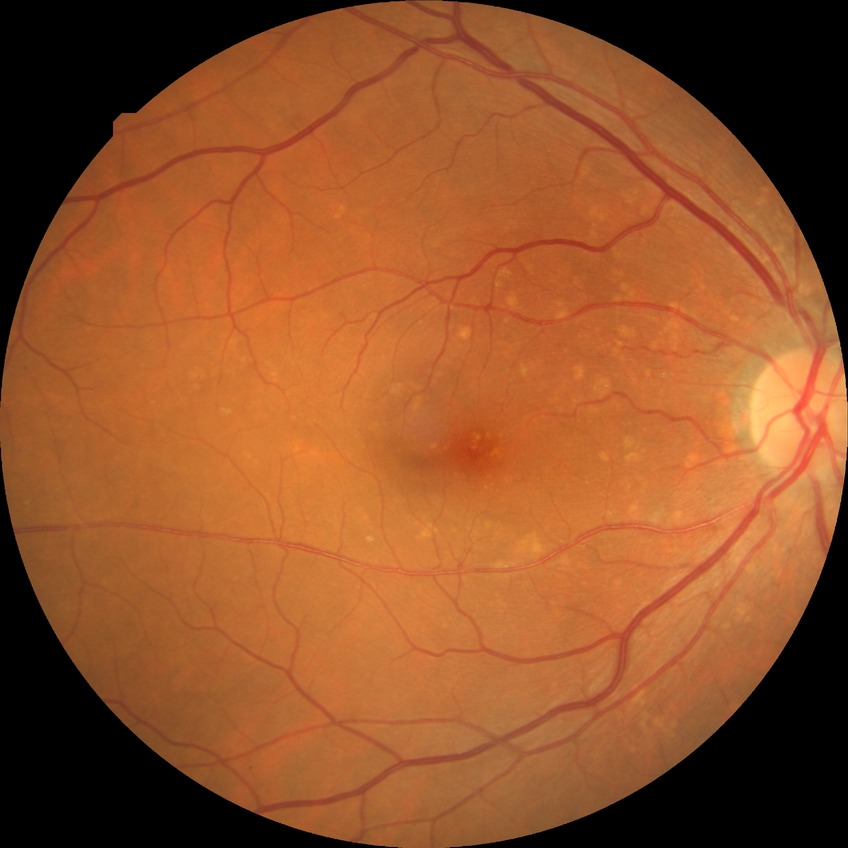
diabetic retinopathy (DR)@no diabetic retinopathy (NDR).